CFP; image size 2048x1536: 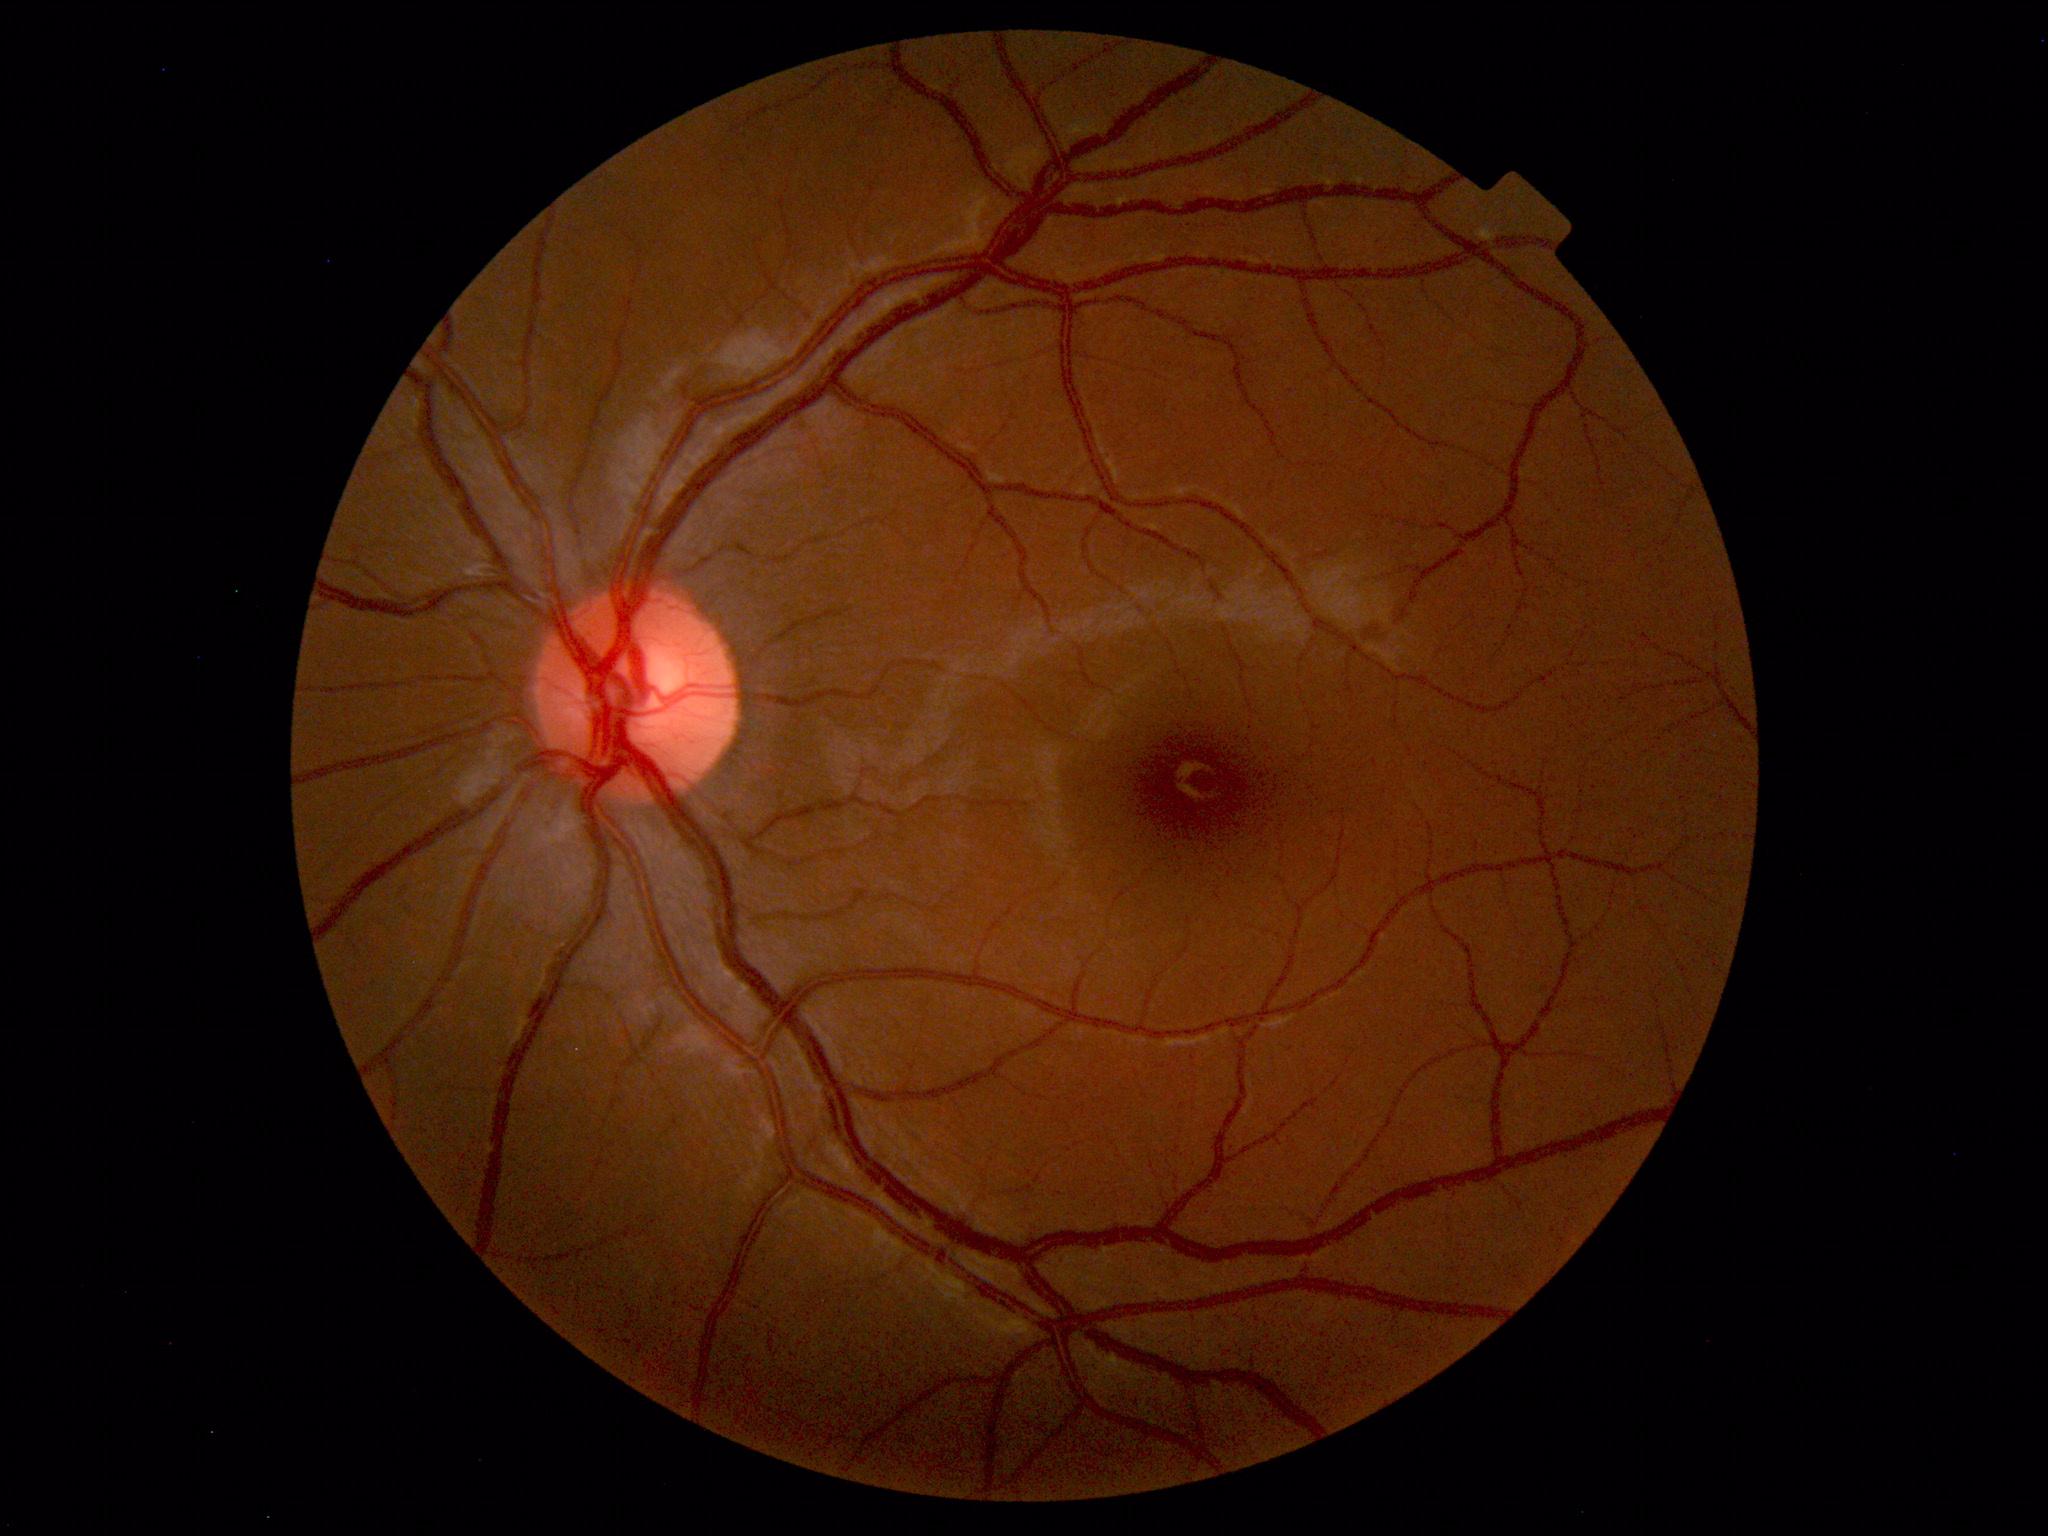
No abnormal findings on fundus examination.